Color fundus image:
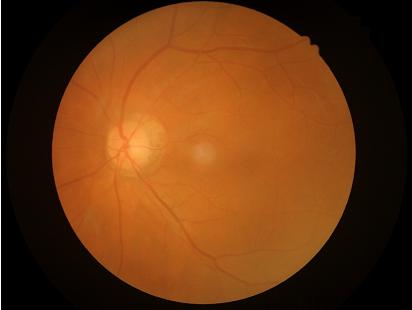 Noticeable blur in the optic disc, vessels, or background.
Illumination is even.
Image quality is inadequate for diagnostic use.